Retinal fundus photograph:
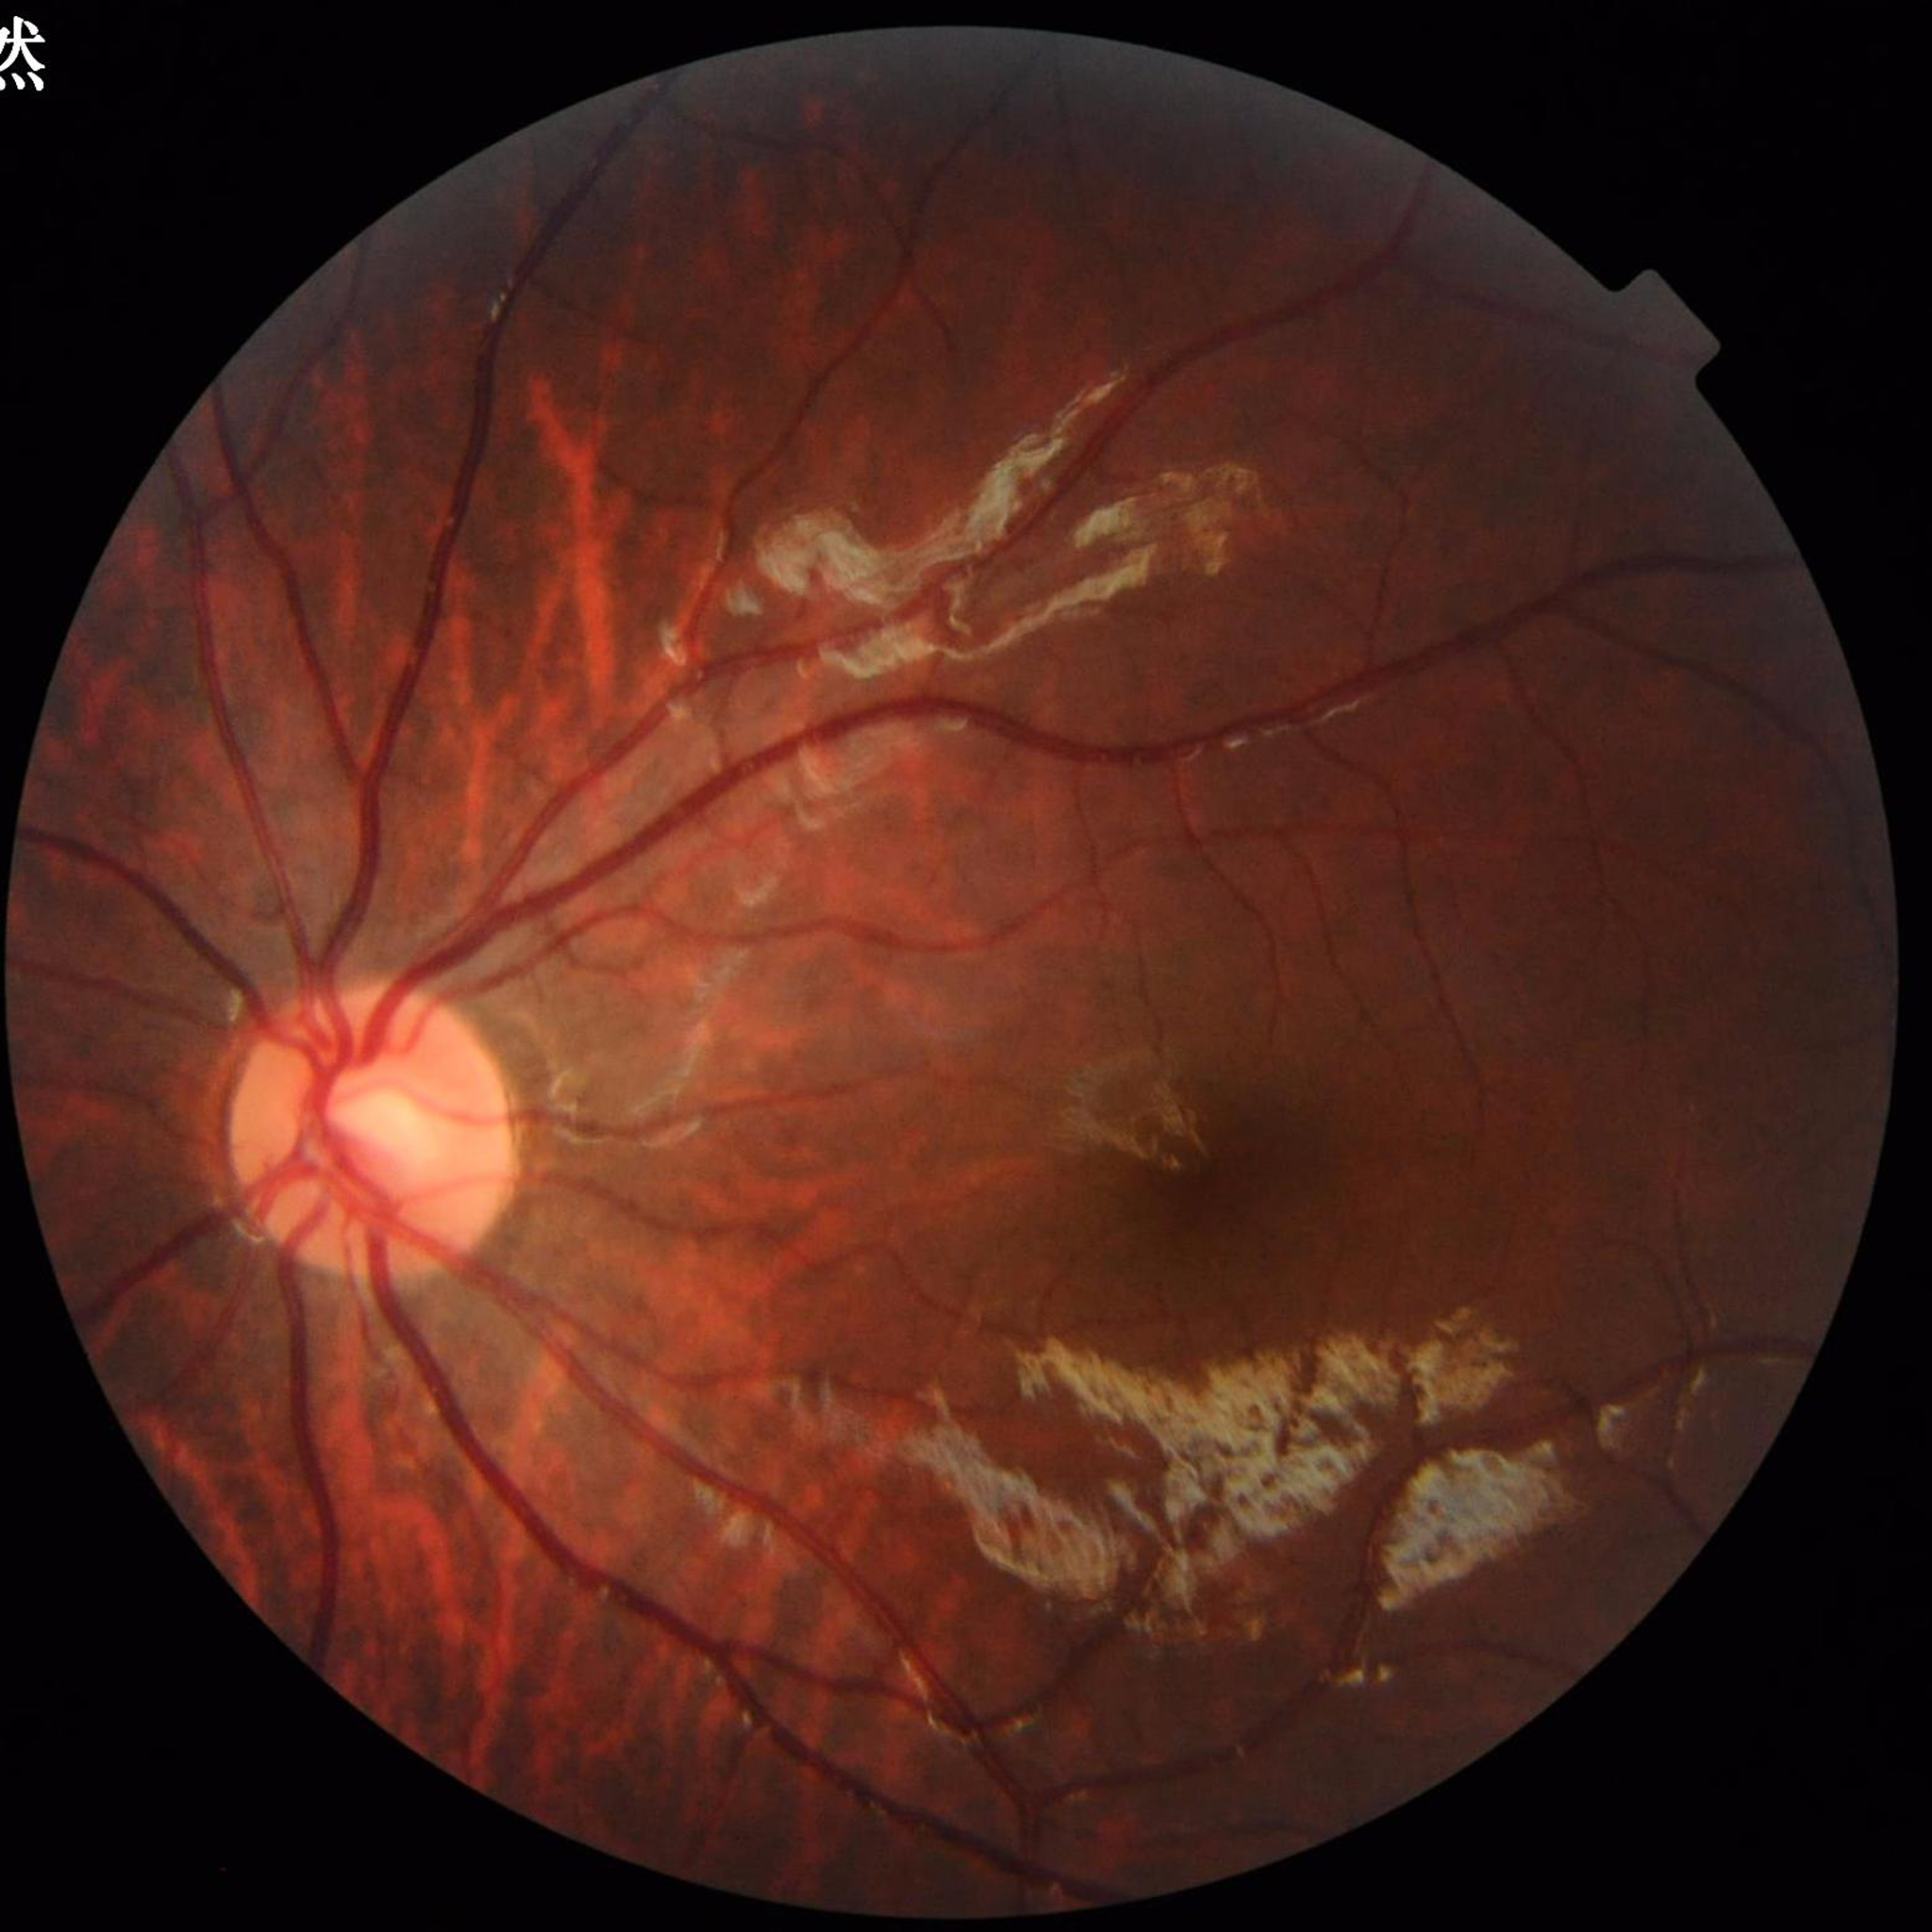

Automated quality assessment = good | Disease = no AMD, DR, or glaucomatous findings.